Field includes the optic disc and macula. 50° field of view. Dilated-pupil acquisition: 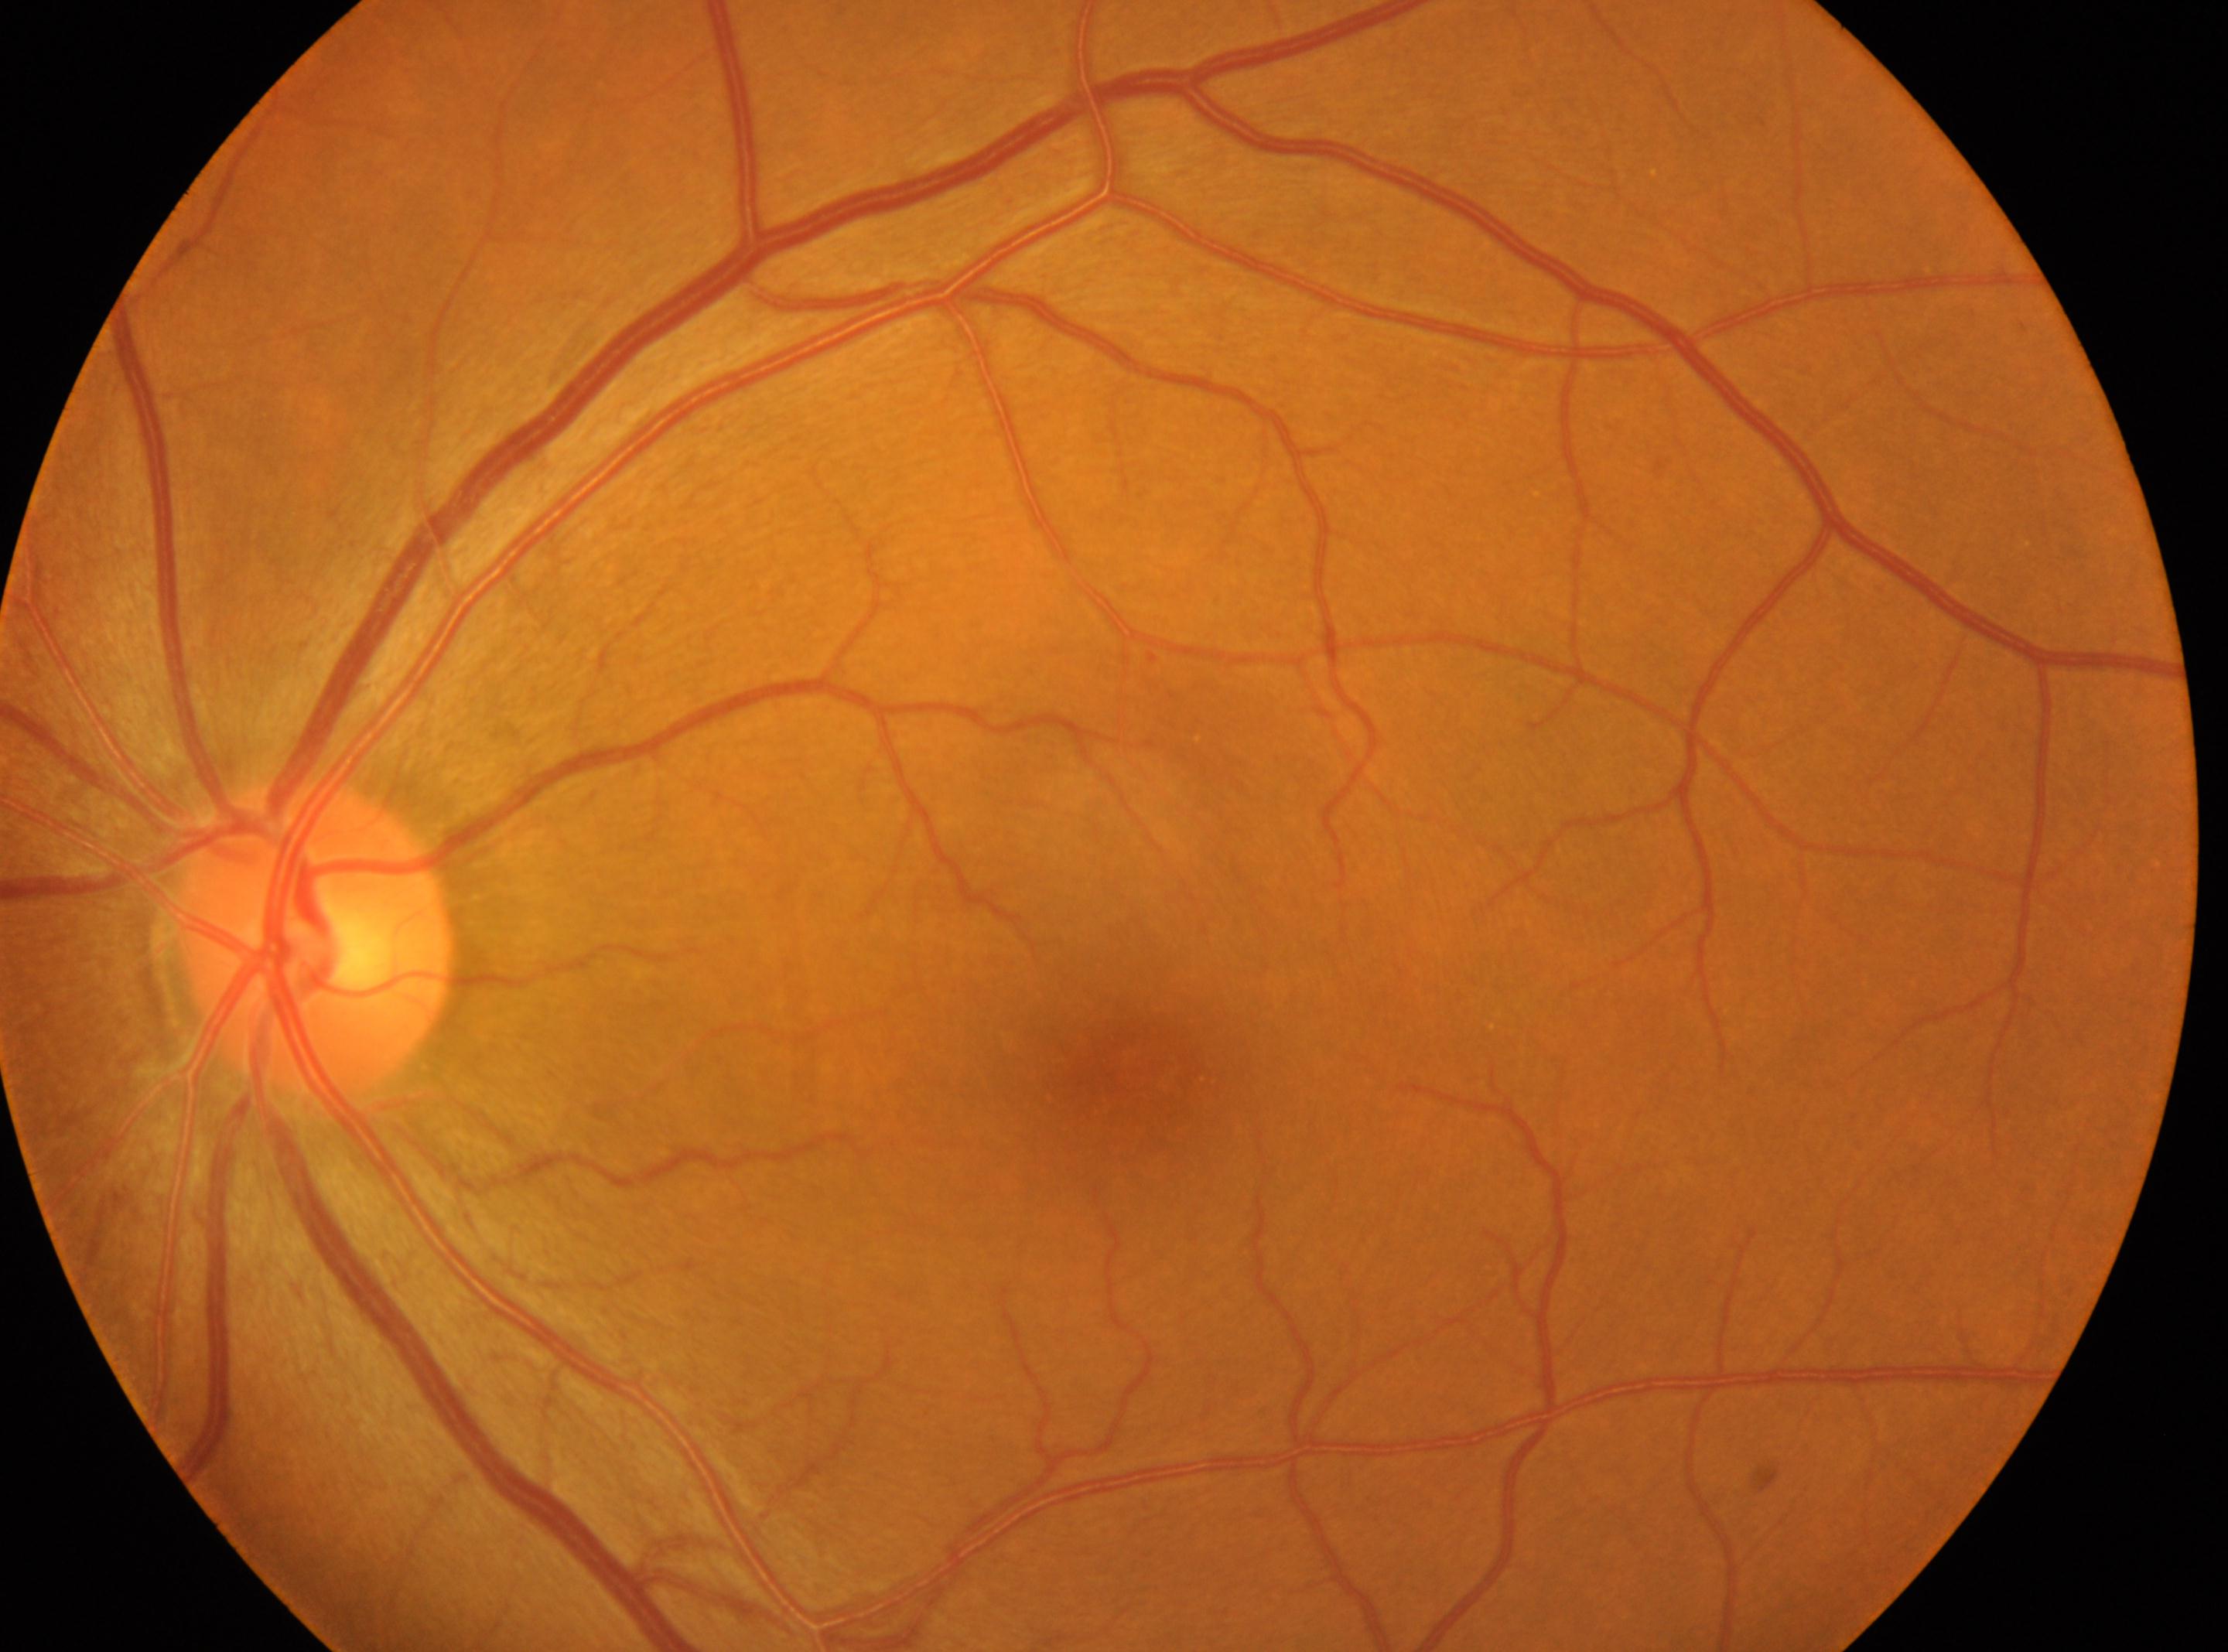
DR severity: grade 1 (mild NPDR) — presence of microaneurysms only. Fovea: x=1134, y=1072. Eye: left. The optic disc is at x=316, y=939.